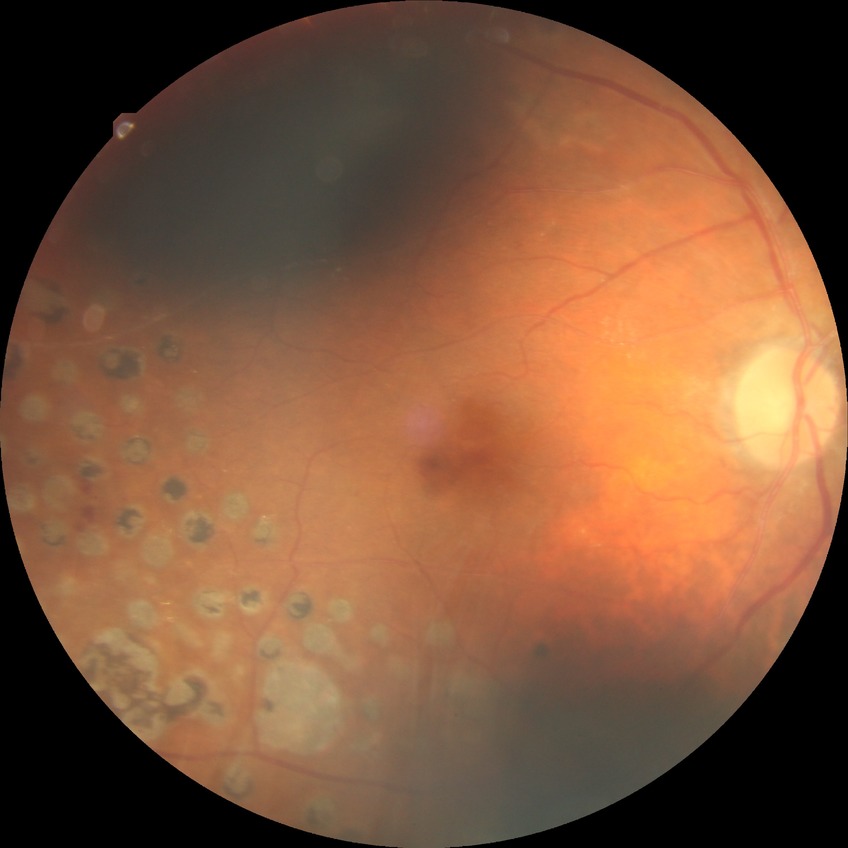

Retinopathy stage is proliferative diabetic retinopathy.